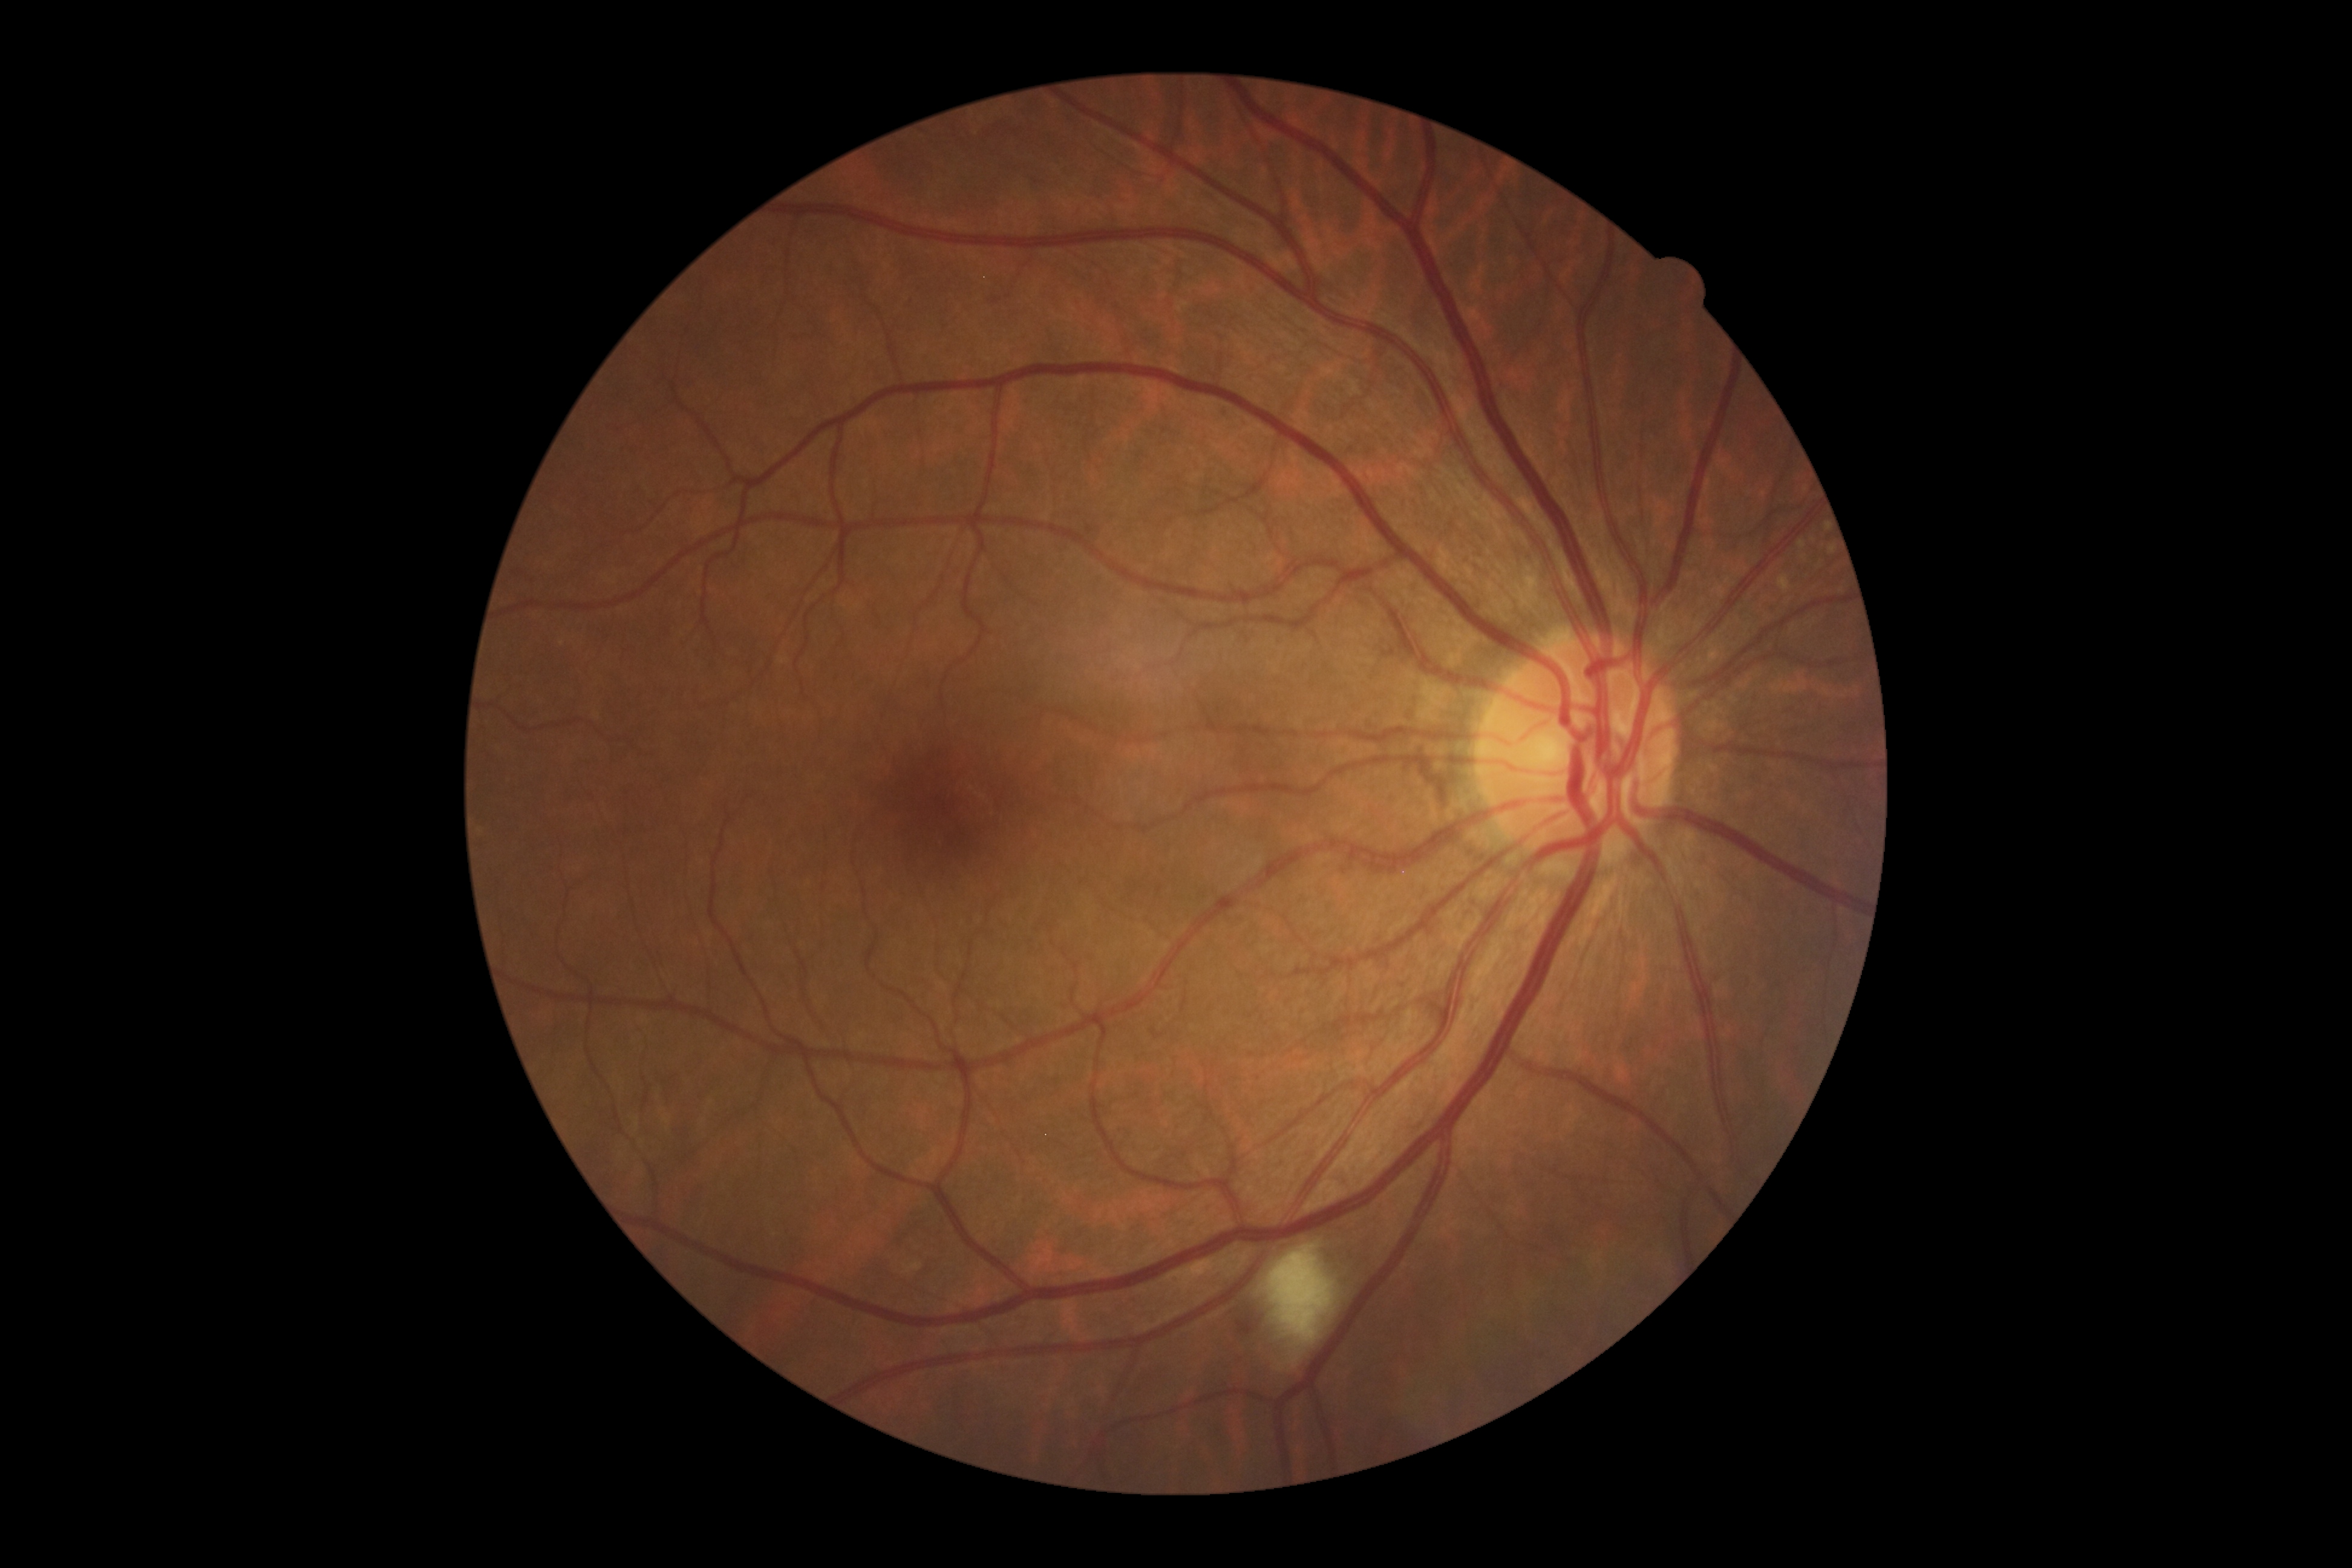 DR is moderate NPDR (grade 2).